Wide-field fundus photograph from neonatal ROP screening; 1240x1240; captured with the Phoenix ICON (100° field of view)
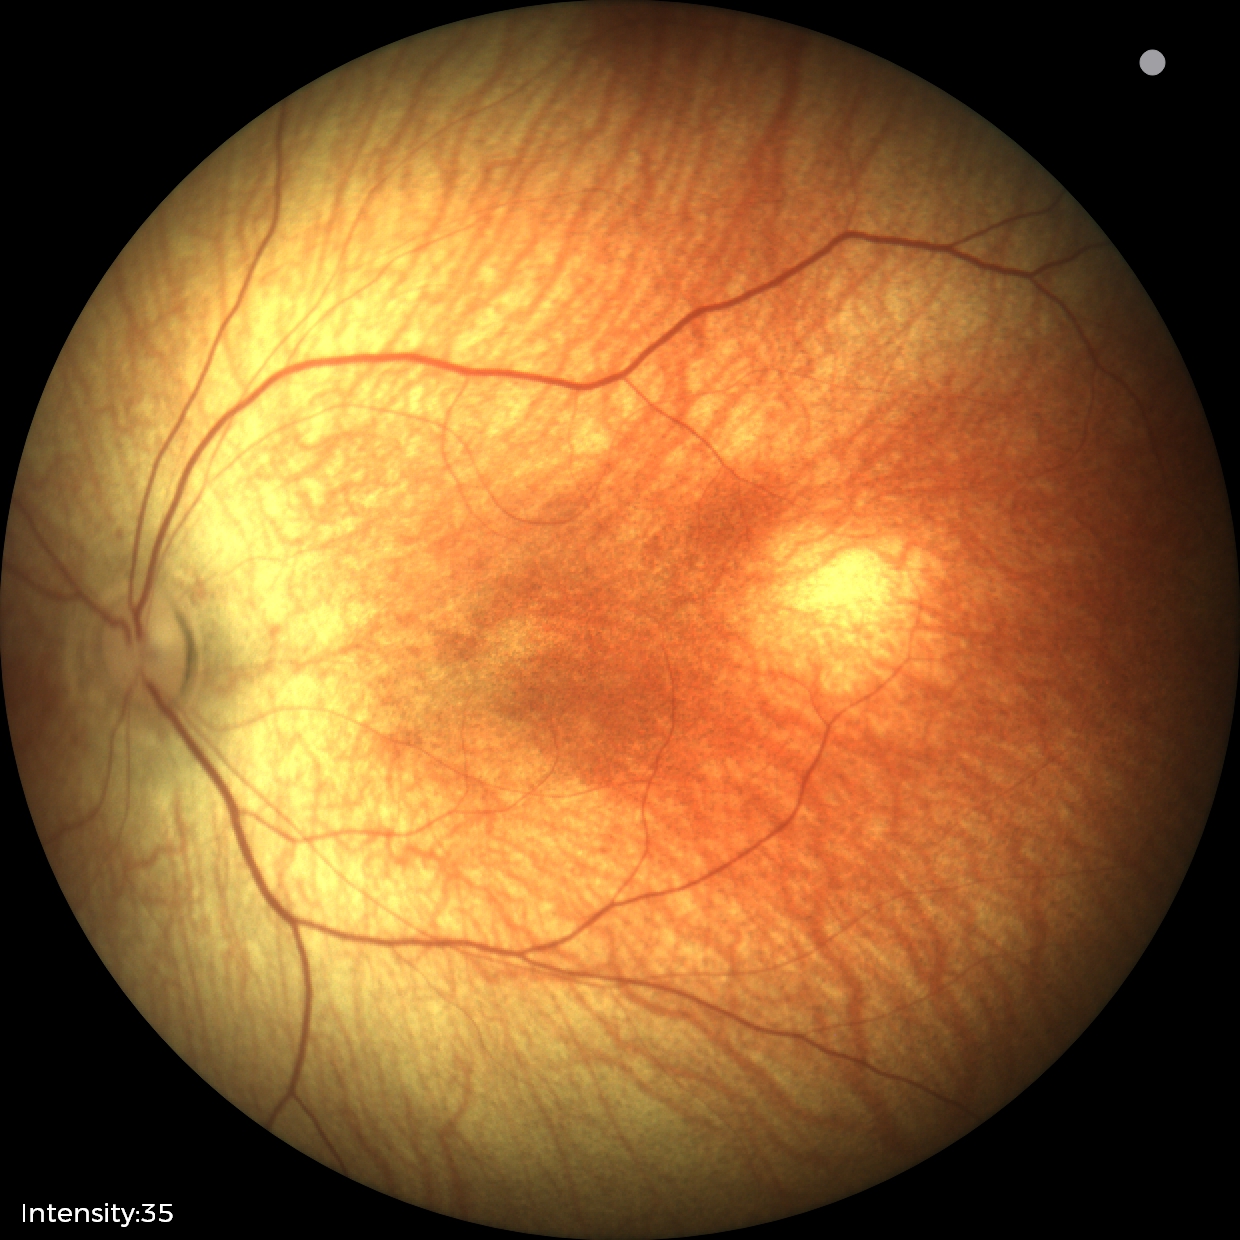 Screening examination with no abnormal retinal findings.